Image size 1971x1876 — 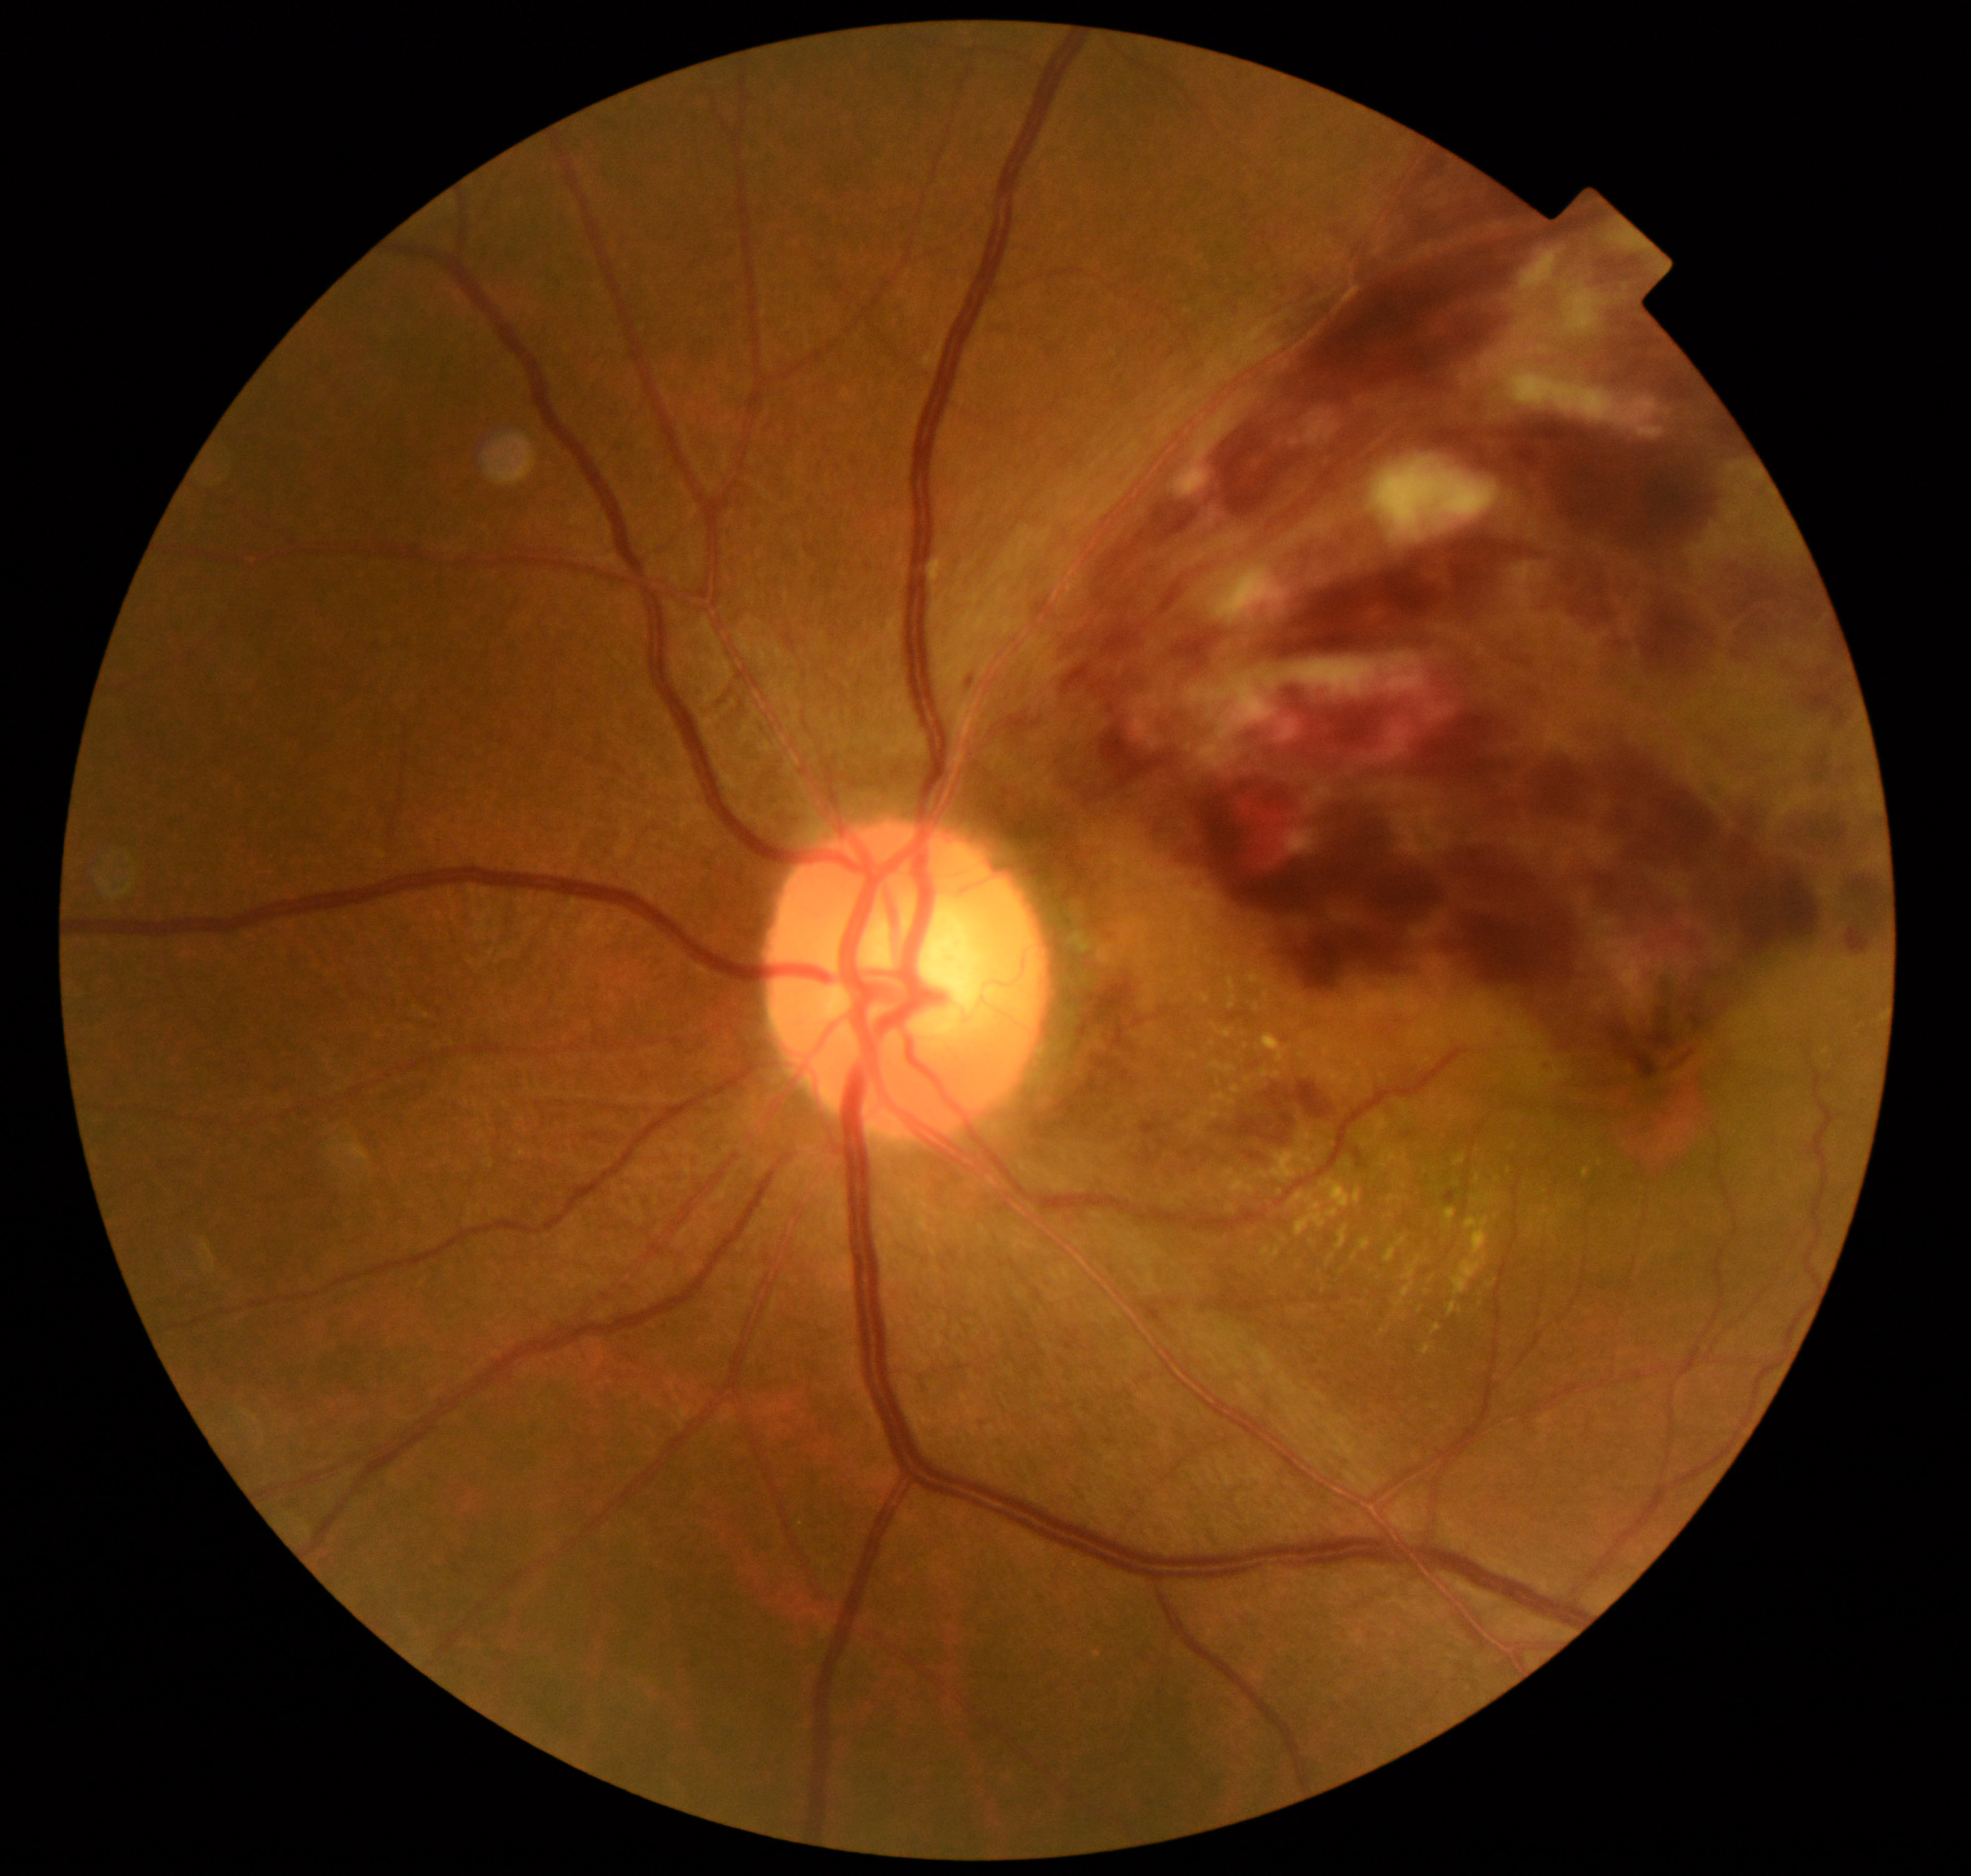 Consistent with branch retinal vein occlusion. Features include tortuosity and dilatation of affected veins, with dot, blot, and flame hemorrhages, sometimes with cotton-wool spots or hard exudates.